Image size 1440x1080. Infant wide-field fundus photograph: 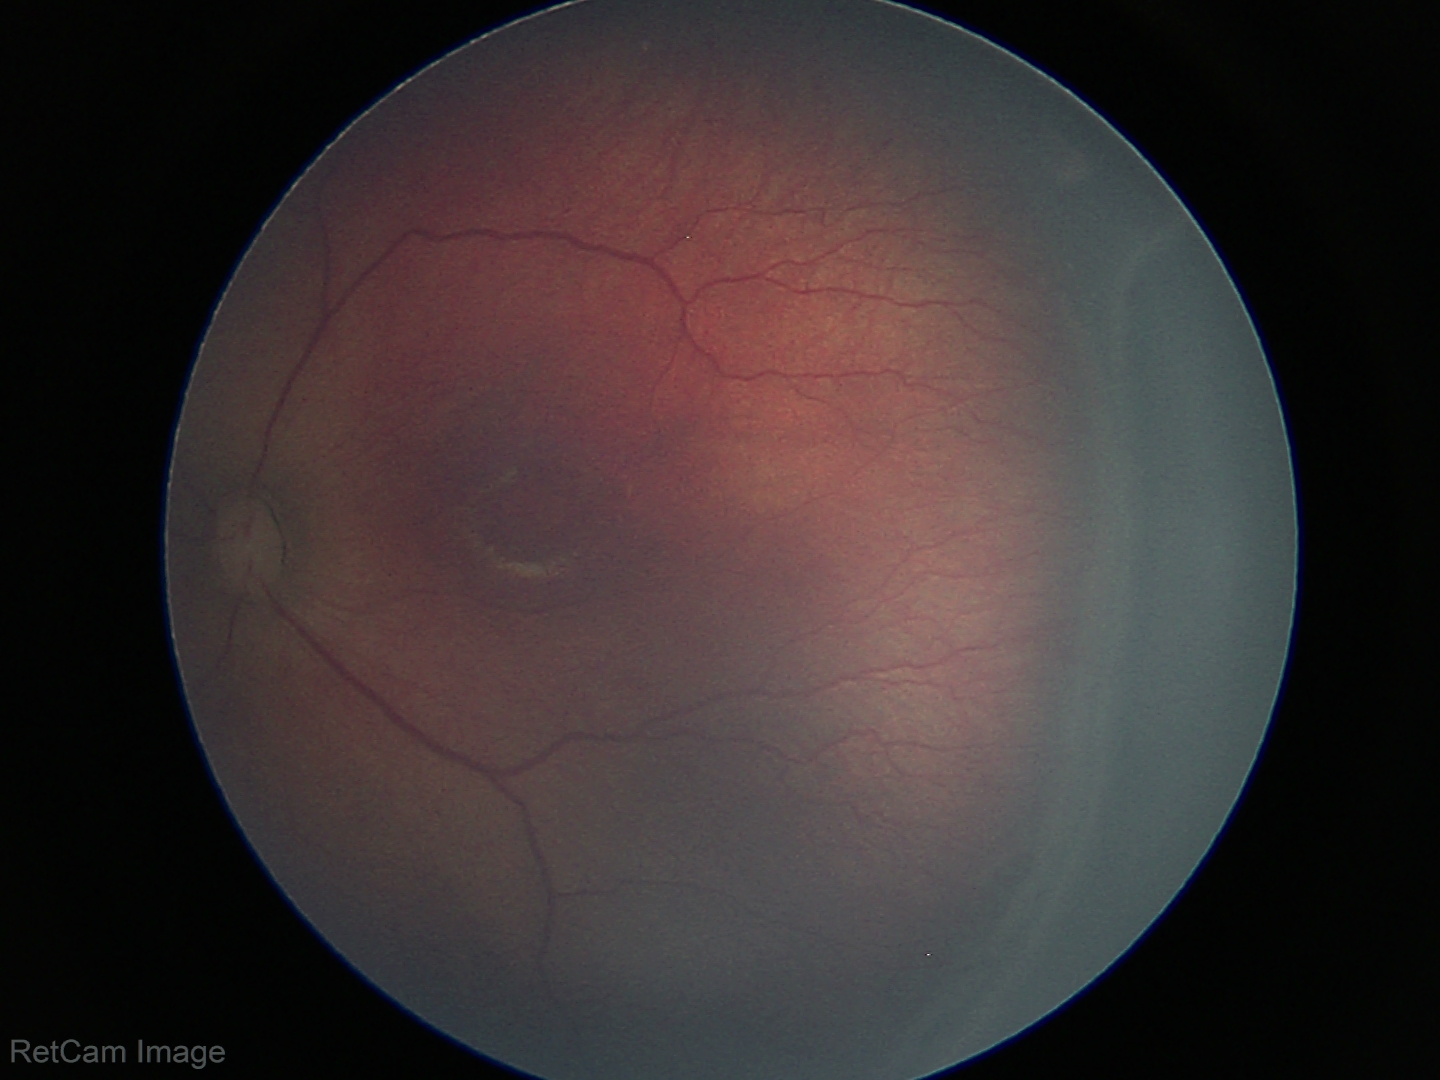
Screening diagnosis: ROP stage 3 | no plus disease.